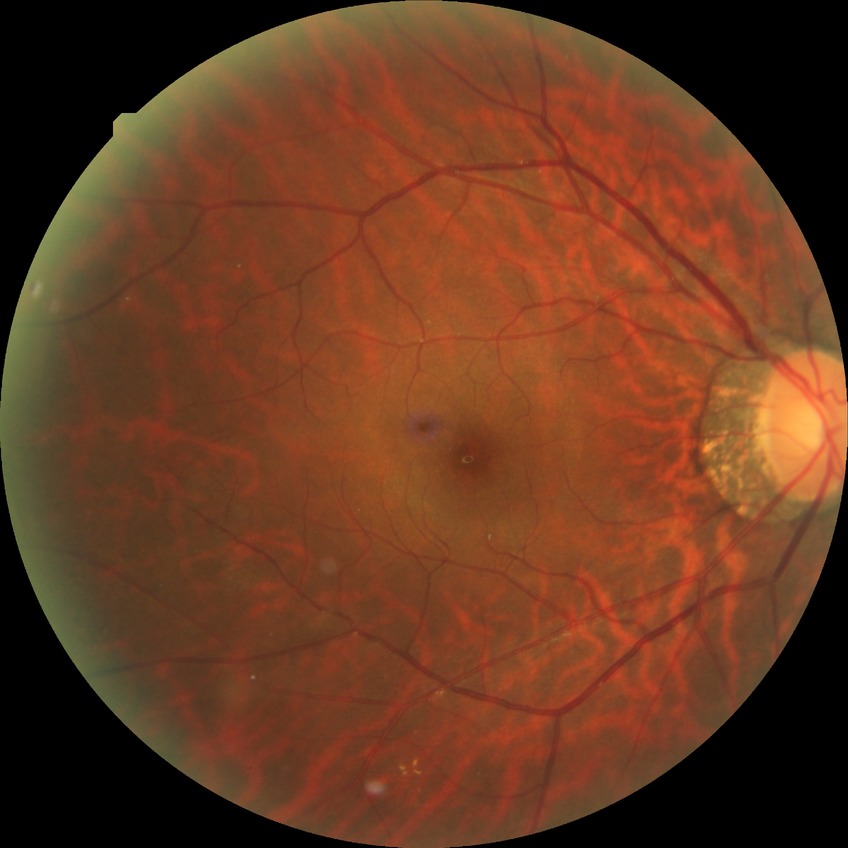 diabetic retinopathy (DR): SDR (simple diabetic retinopathy).